2352x1568:
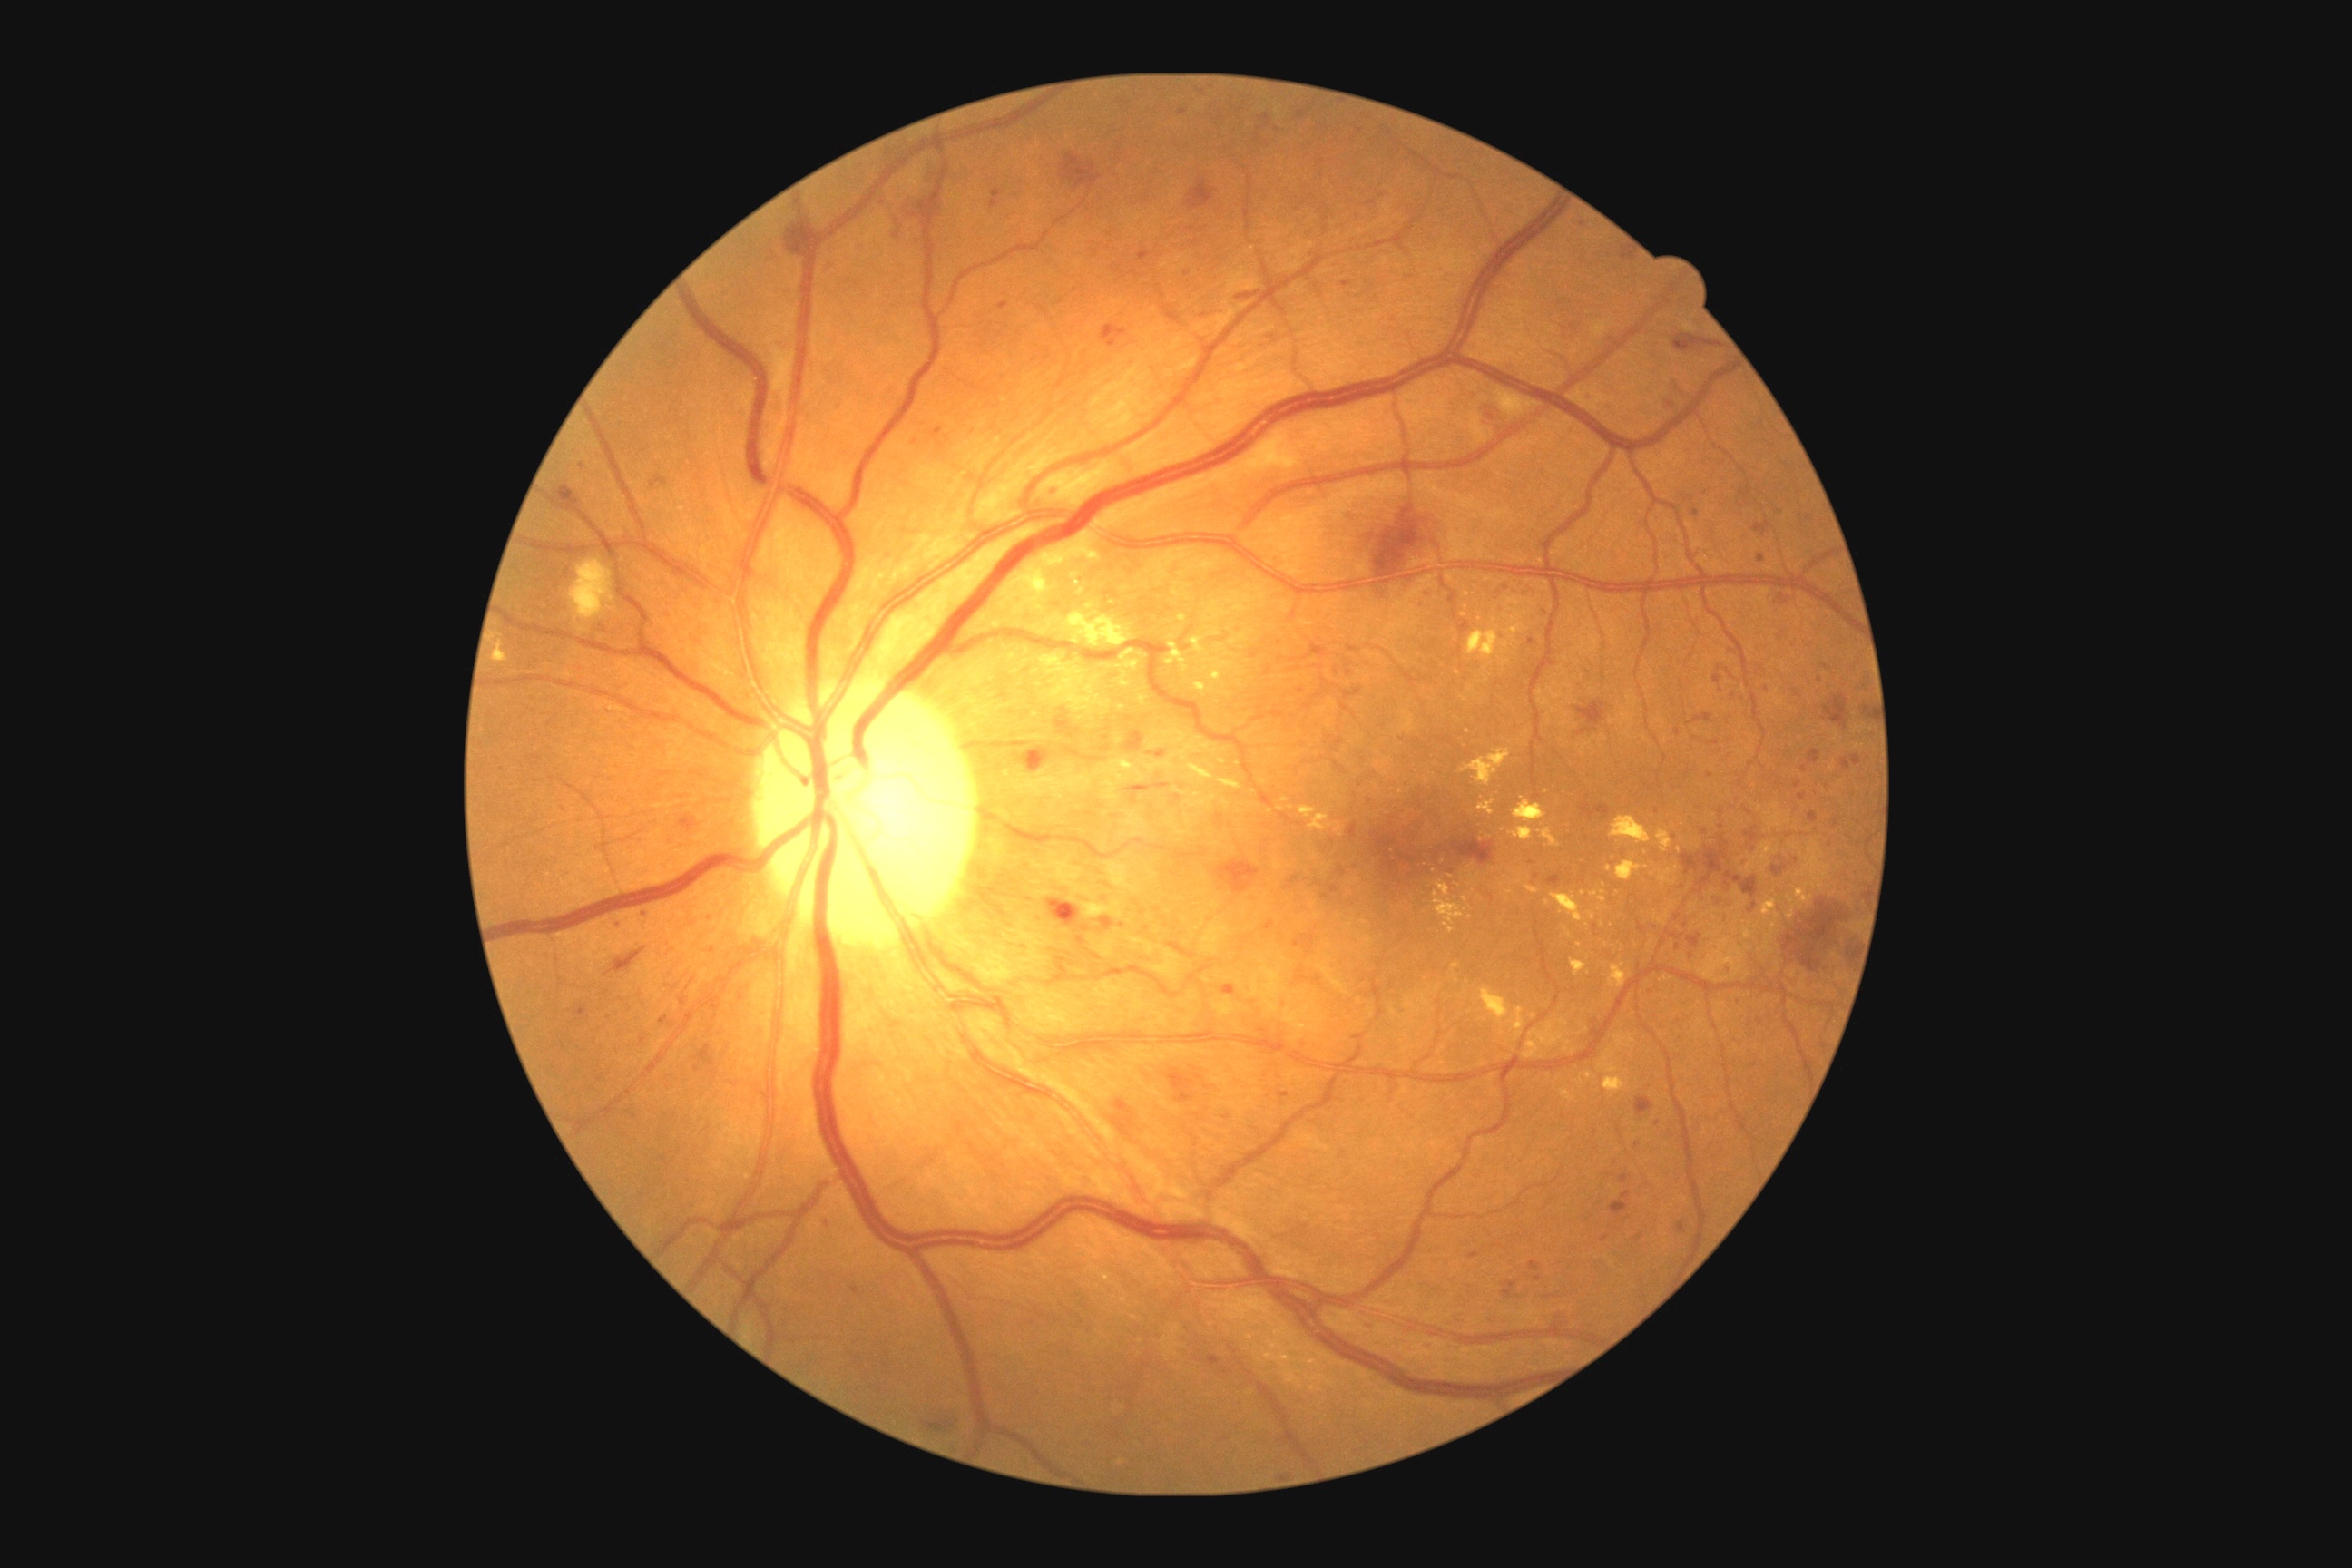
retinopathy = severe NPDR (grade 3), DR class = non-proliferative diabetic retinopathy.